60° field of view; image size 2212x1659: 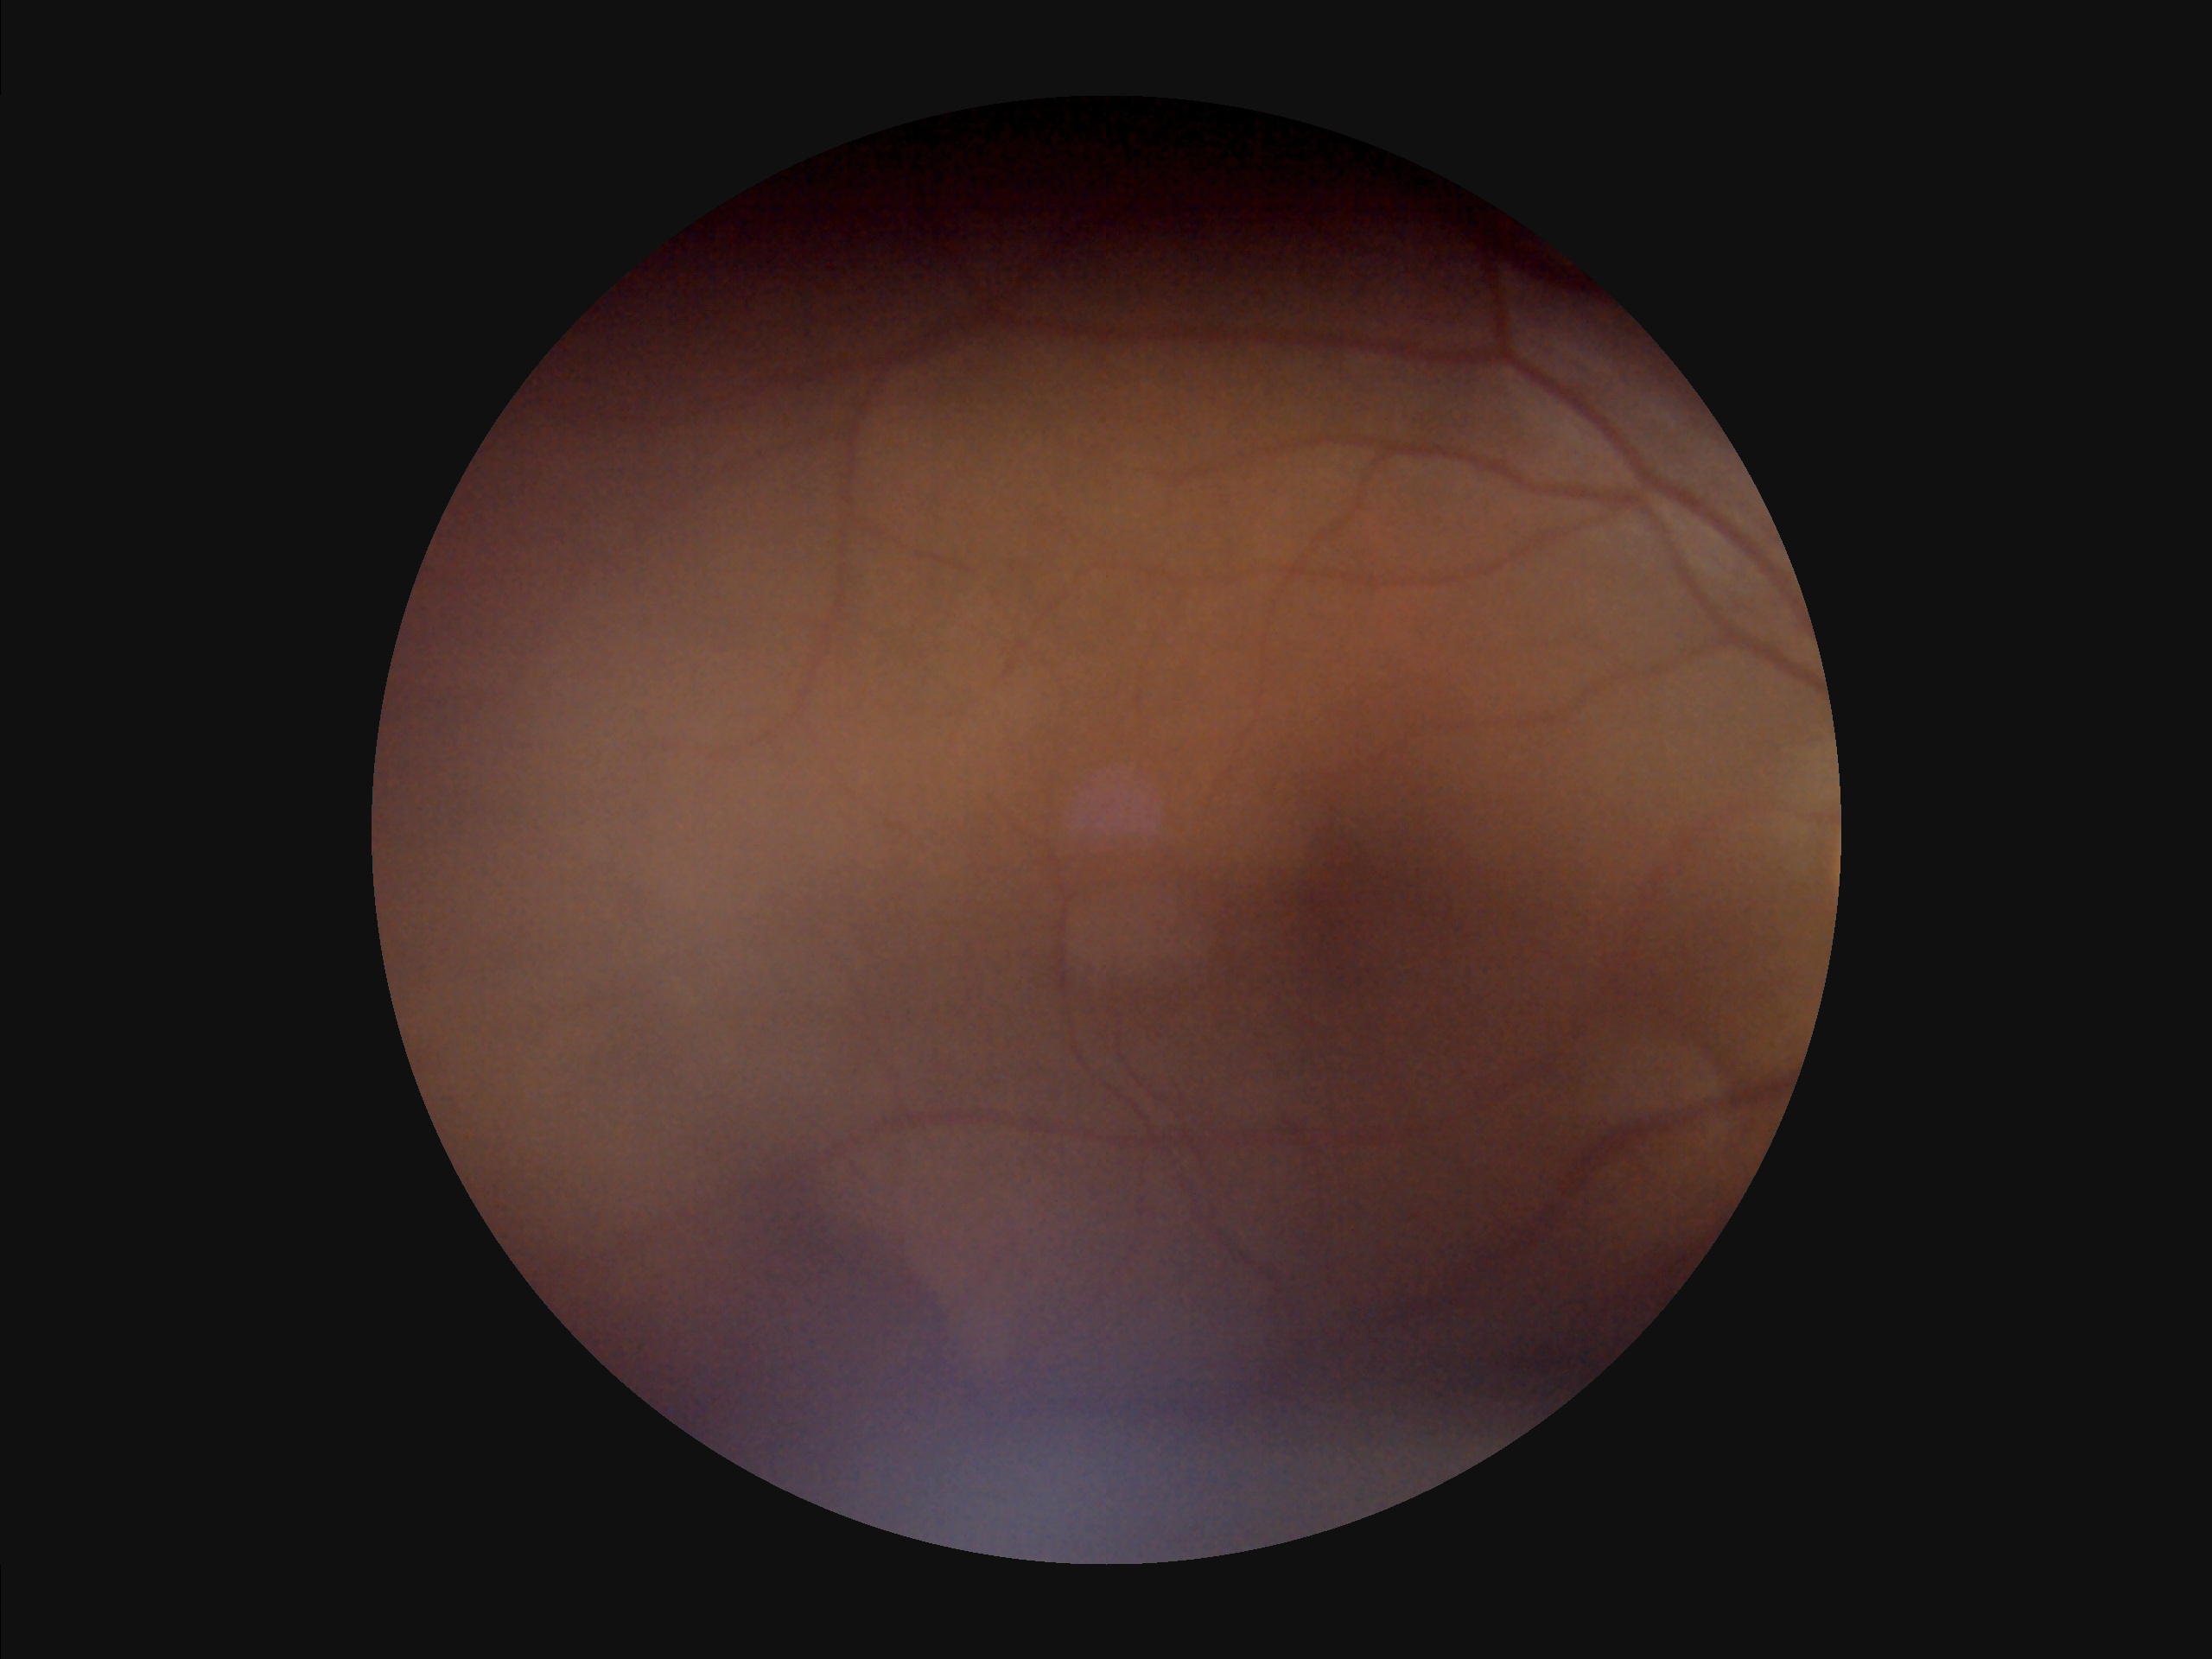

Illumination is uneven.
Narrow intensity range; structures are hard to distinguish.
Image quality is suboptimal.
Reduced sharpness with visible blur.